Image size 1932x1932; fundus photo: 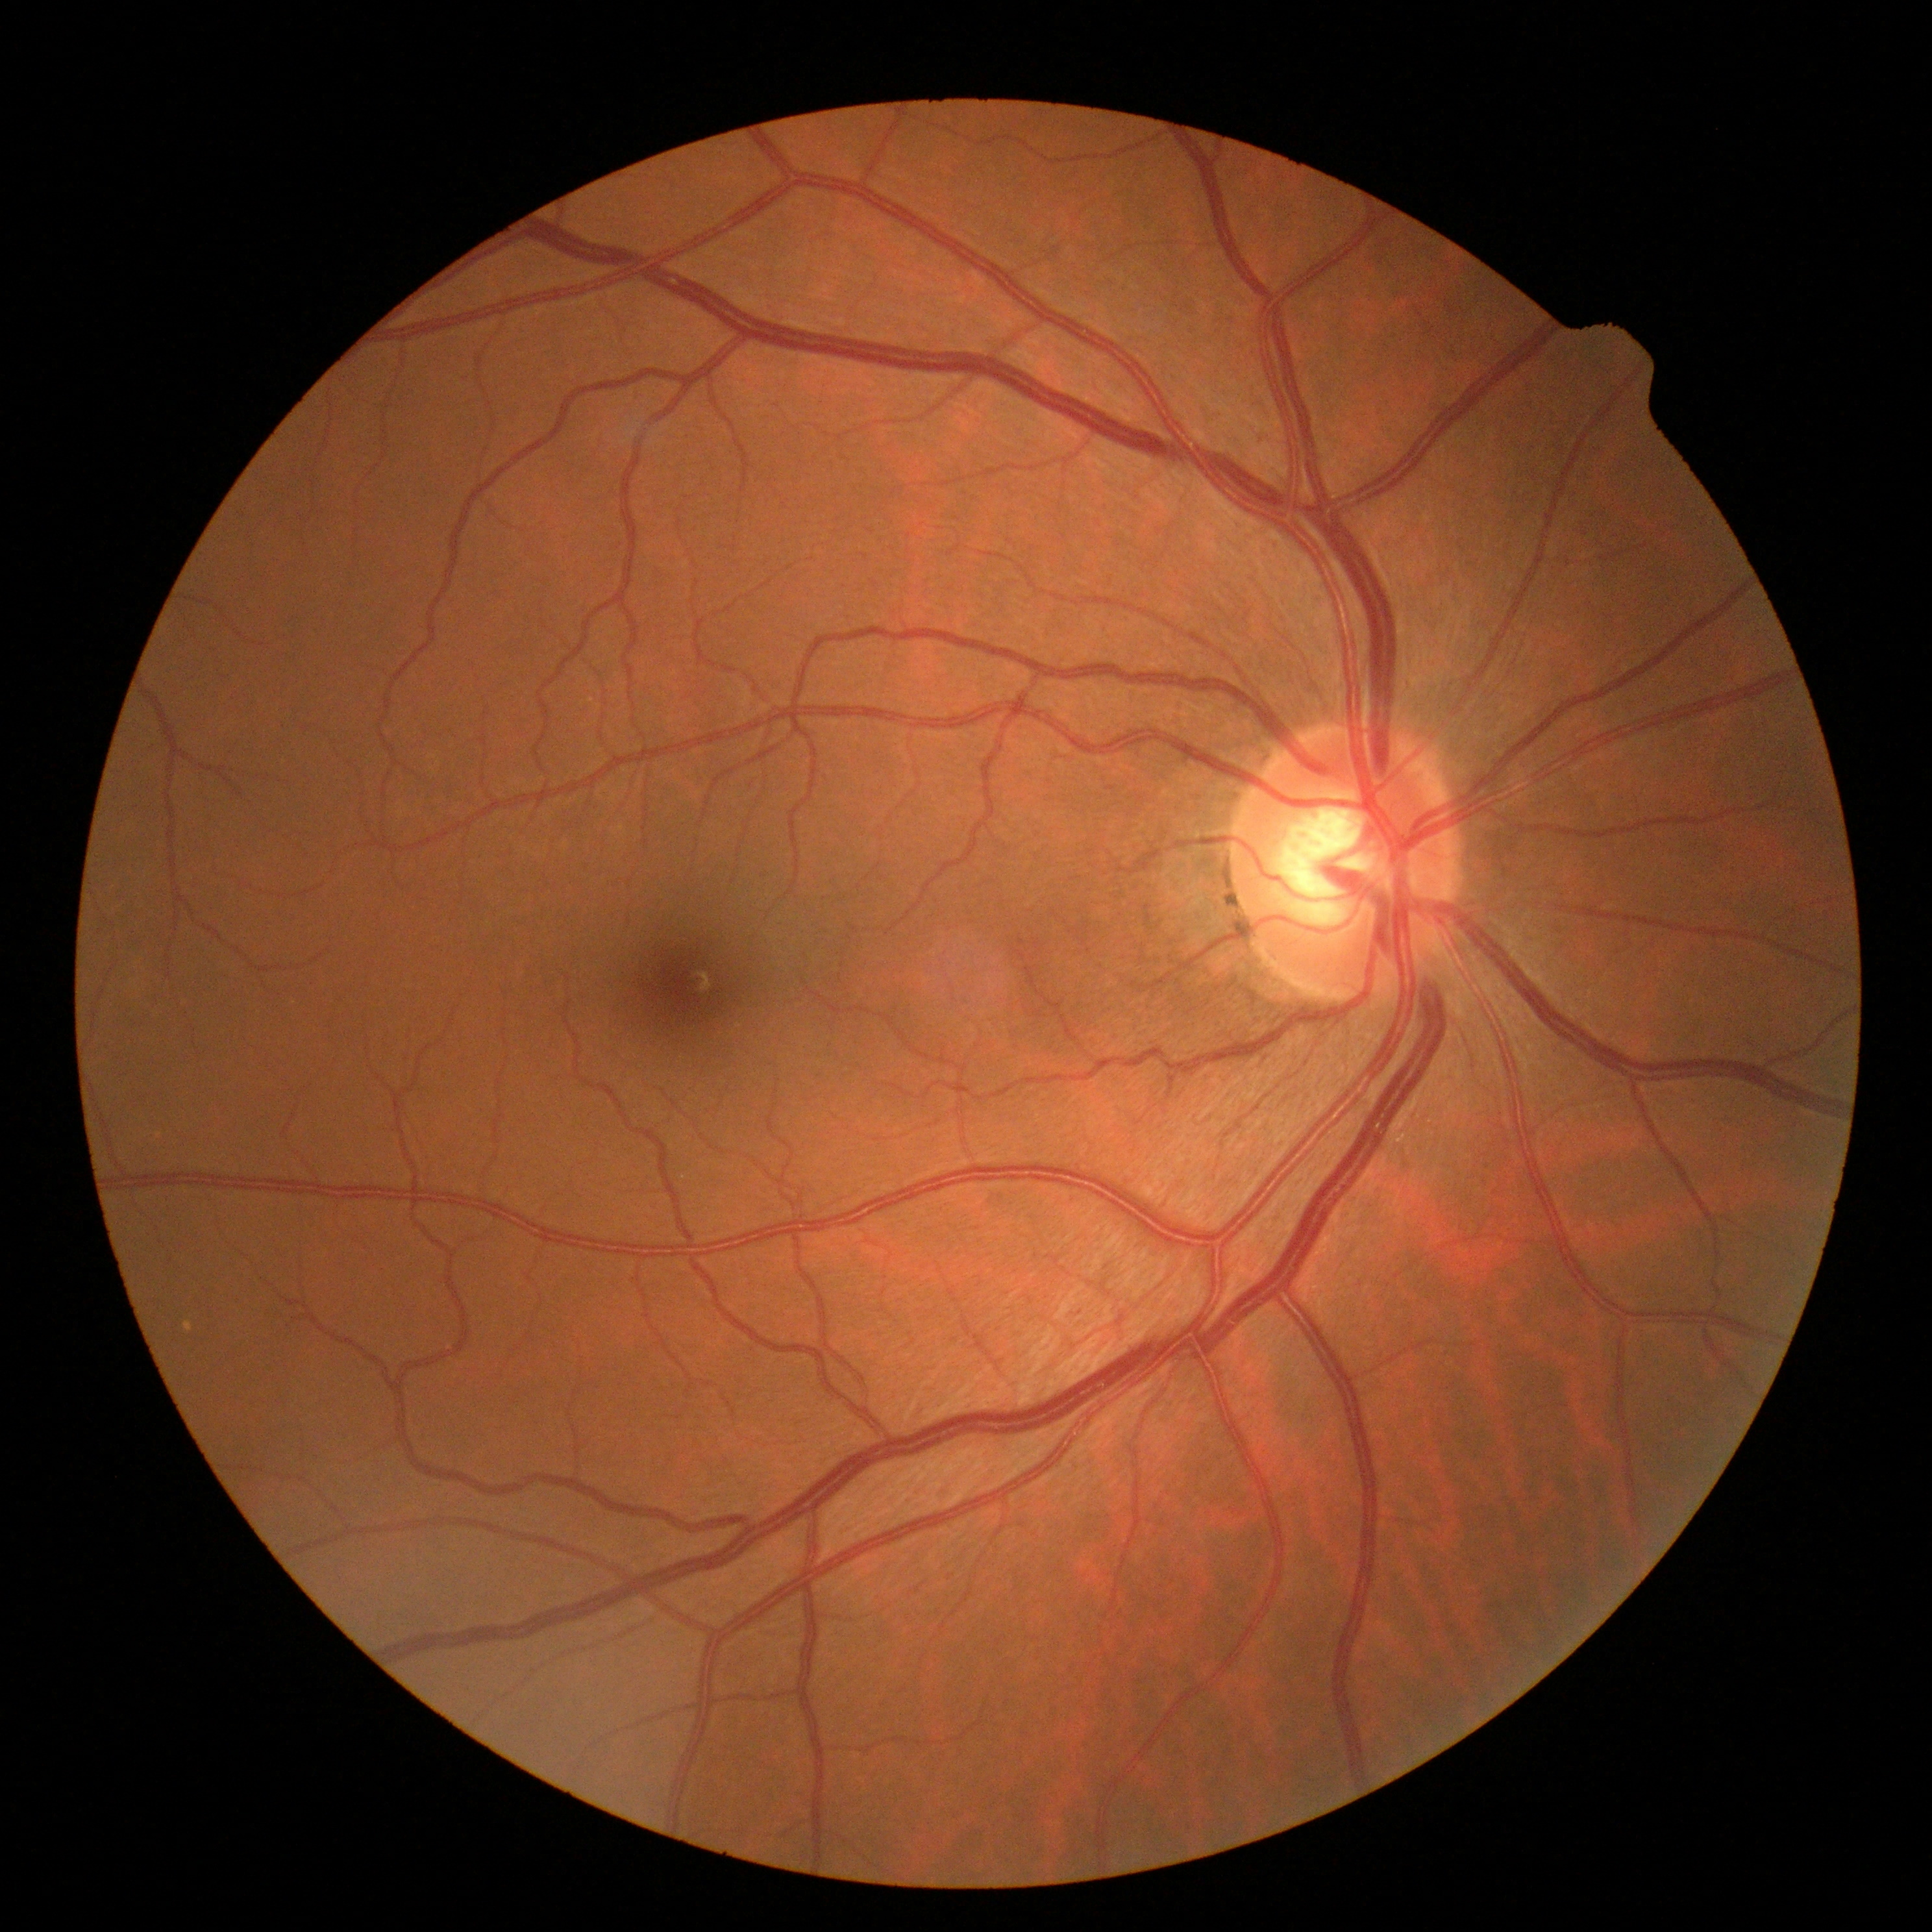

Findings:
* diabetic retinopathy (DR) — grade 0 (no apparent retinopathy)